Nonmydriatic fundus photograph:
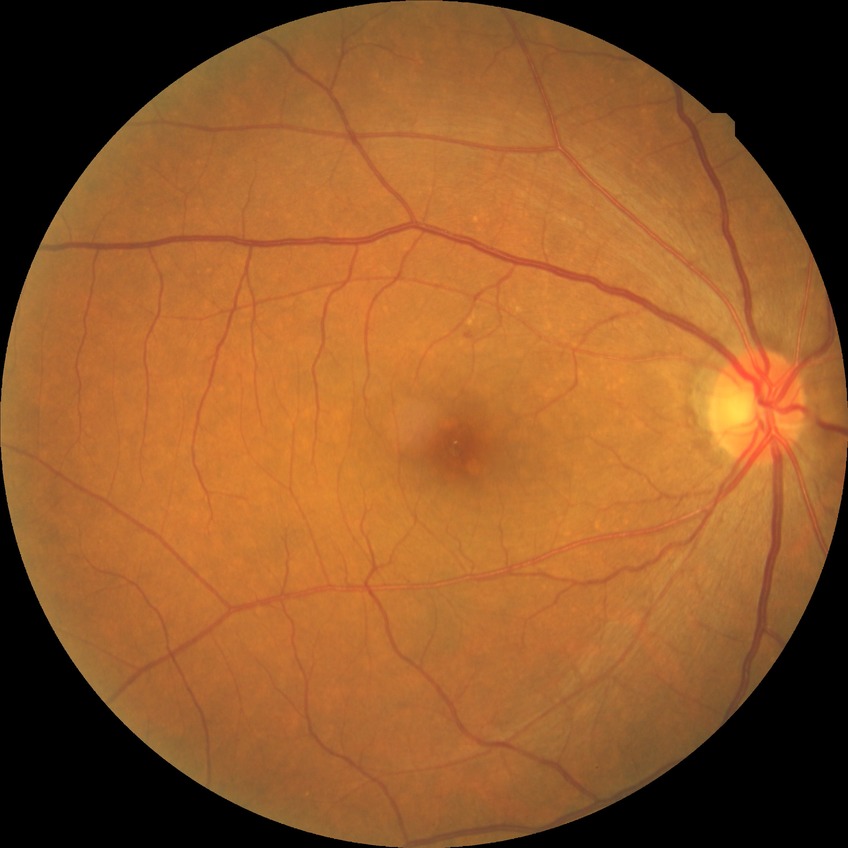
Diabetic retinopathy (DR) is simple diabetic retinopathy (SDR).